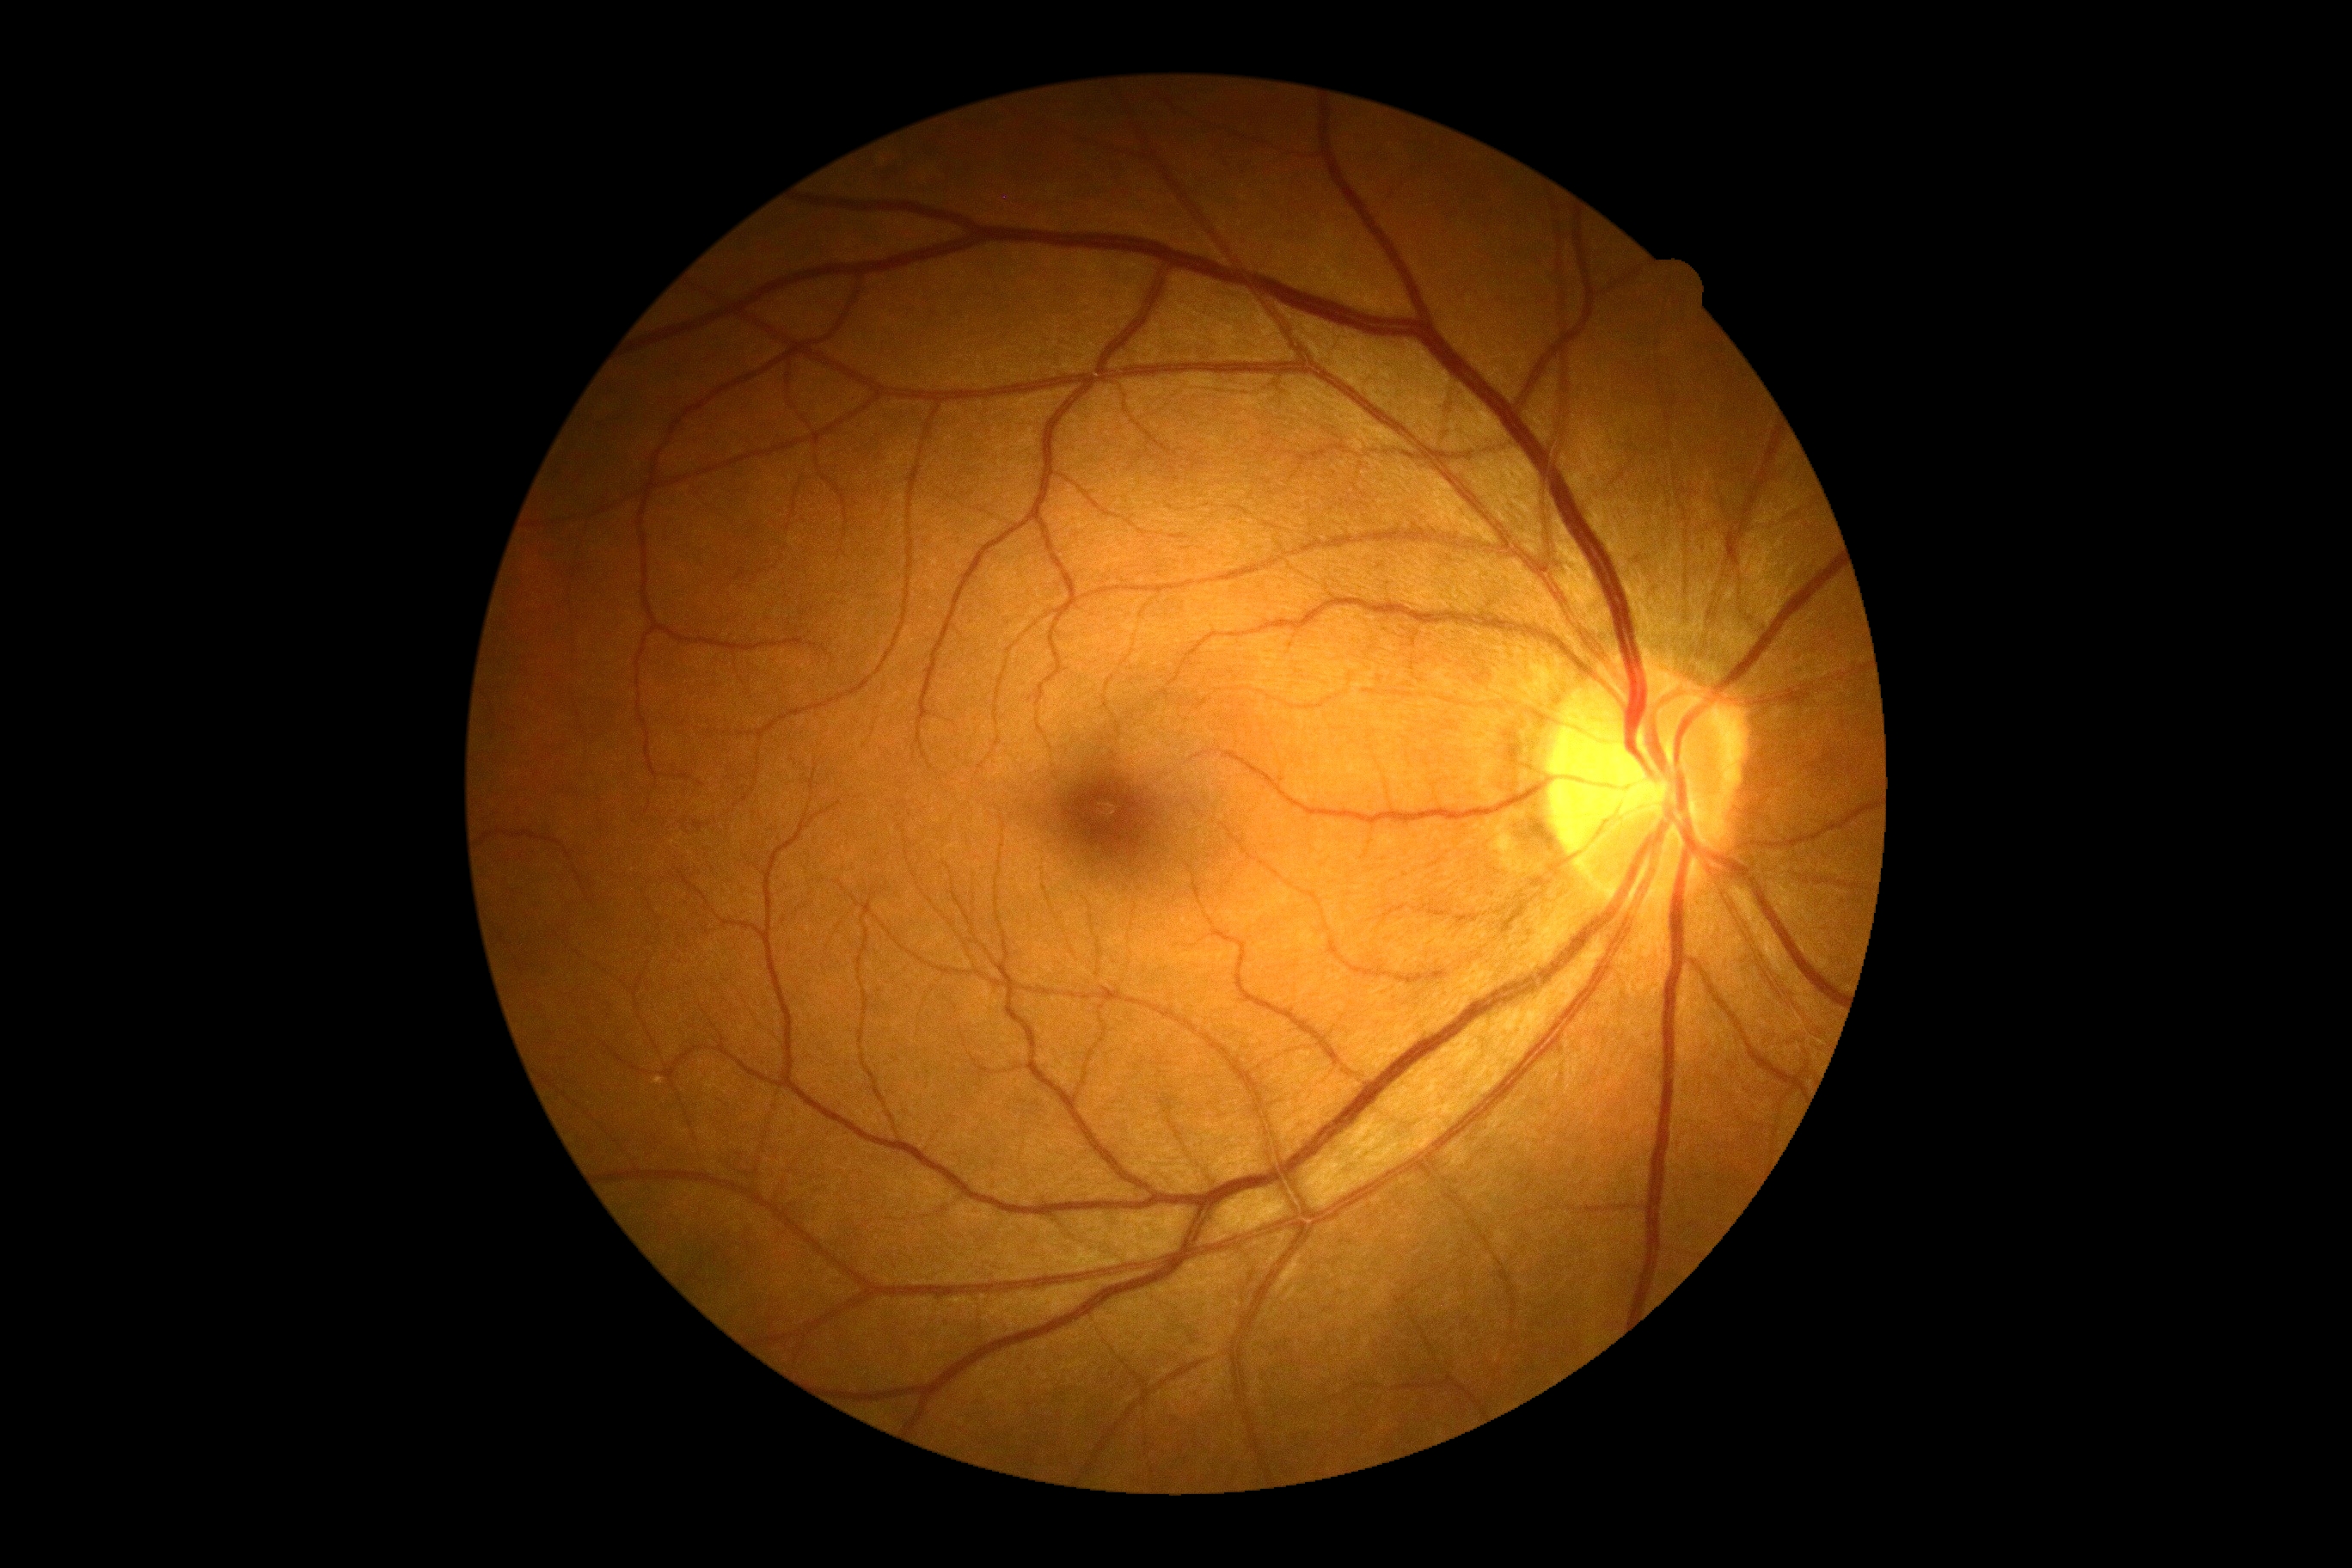

DR@no apparent retinopathy (grade 0) — no visible signs of diabetic retinopathy; DR impression@no DR findings.